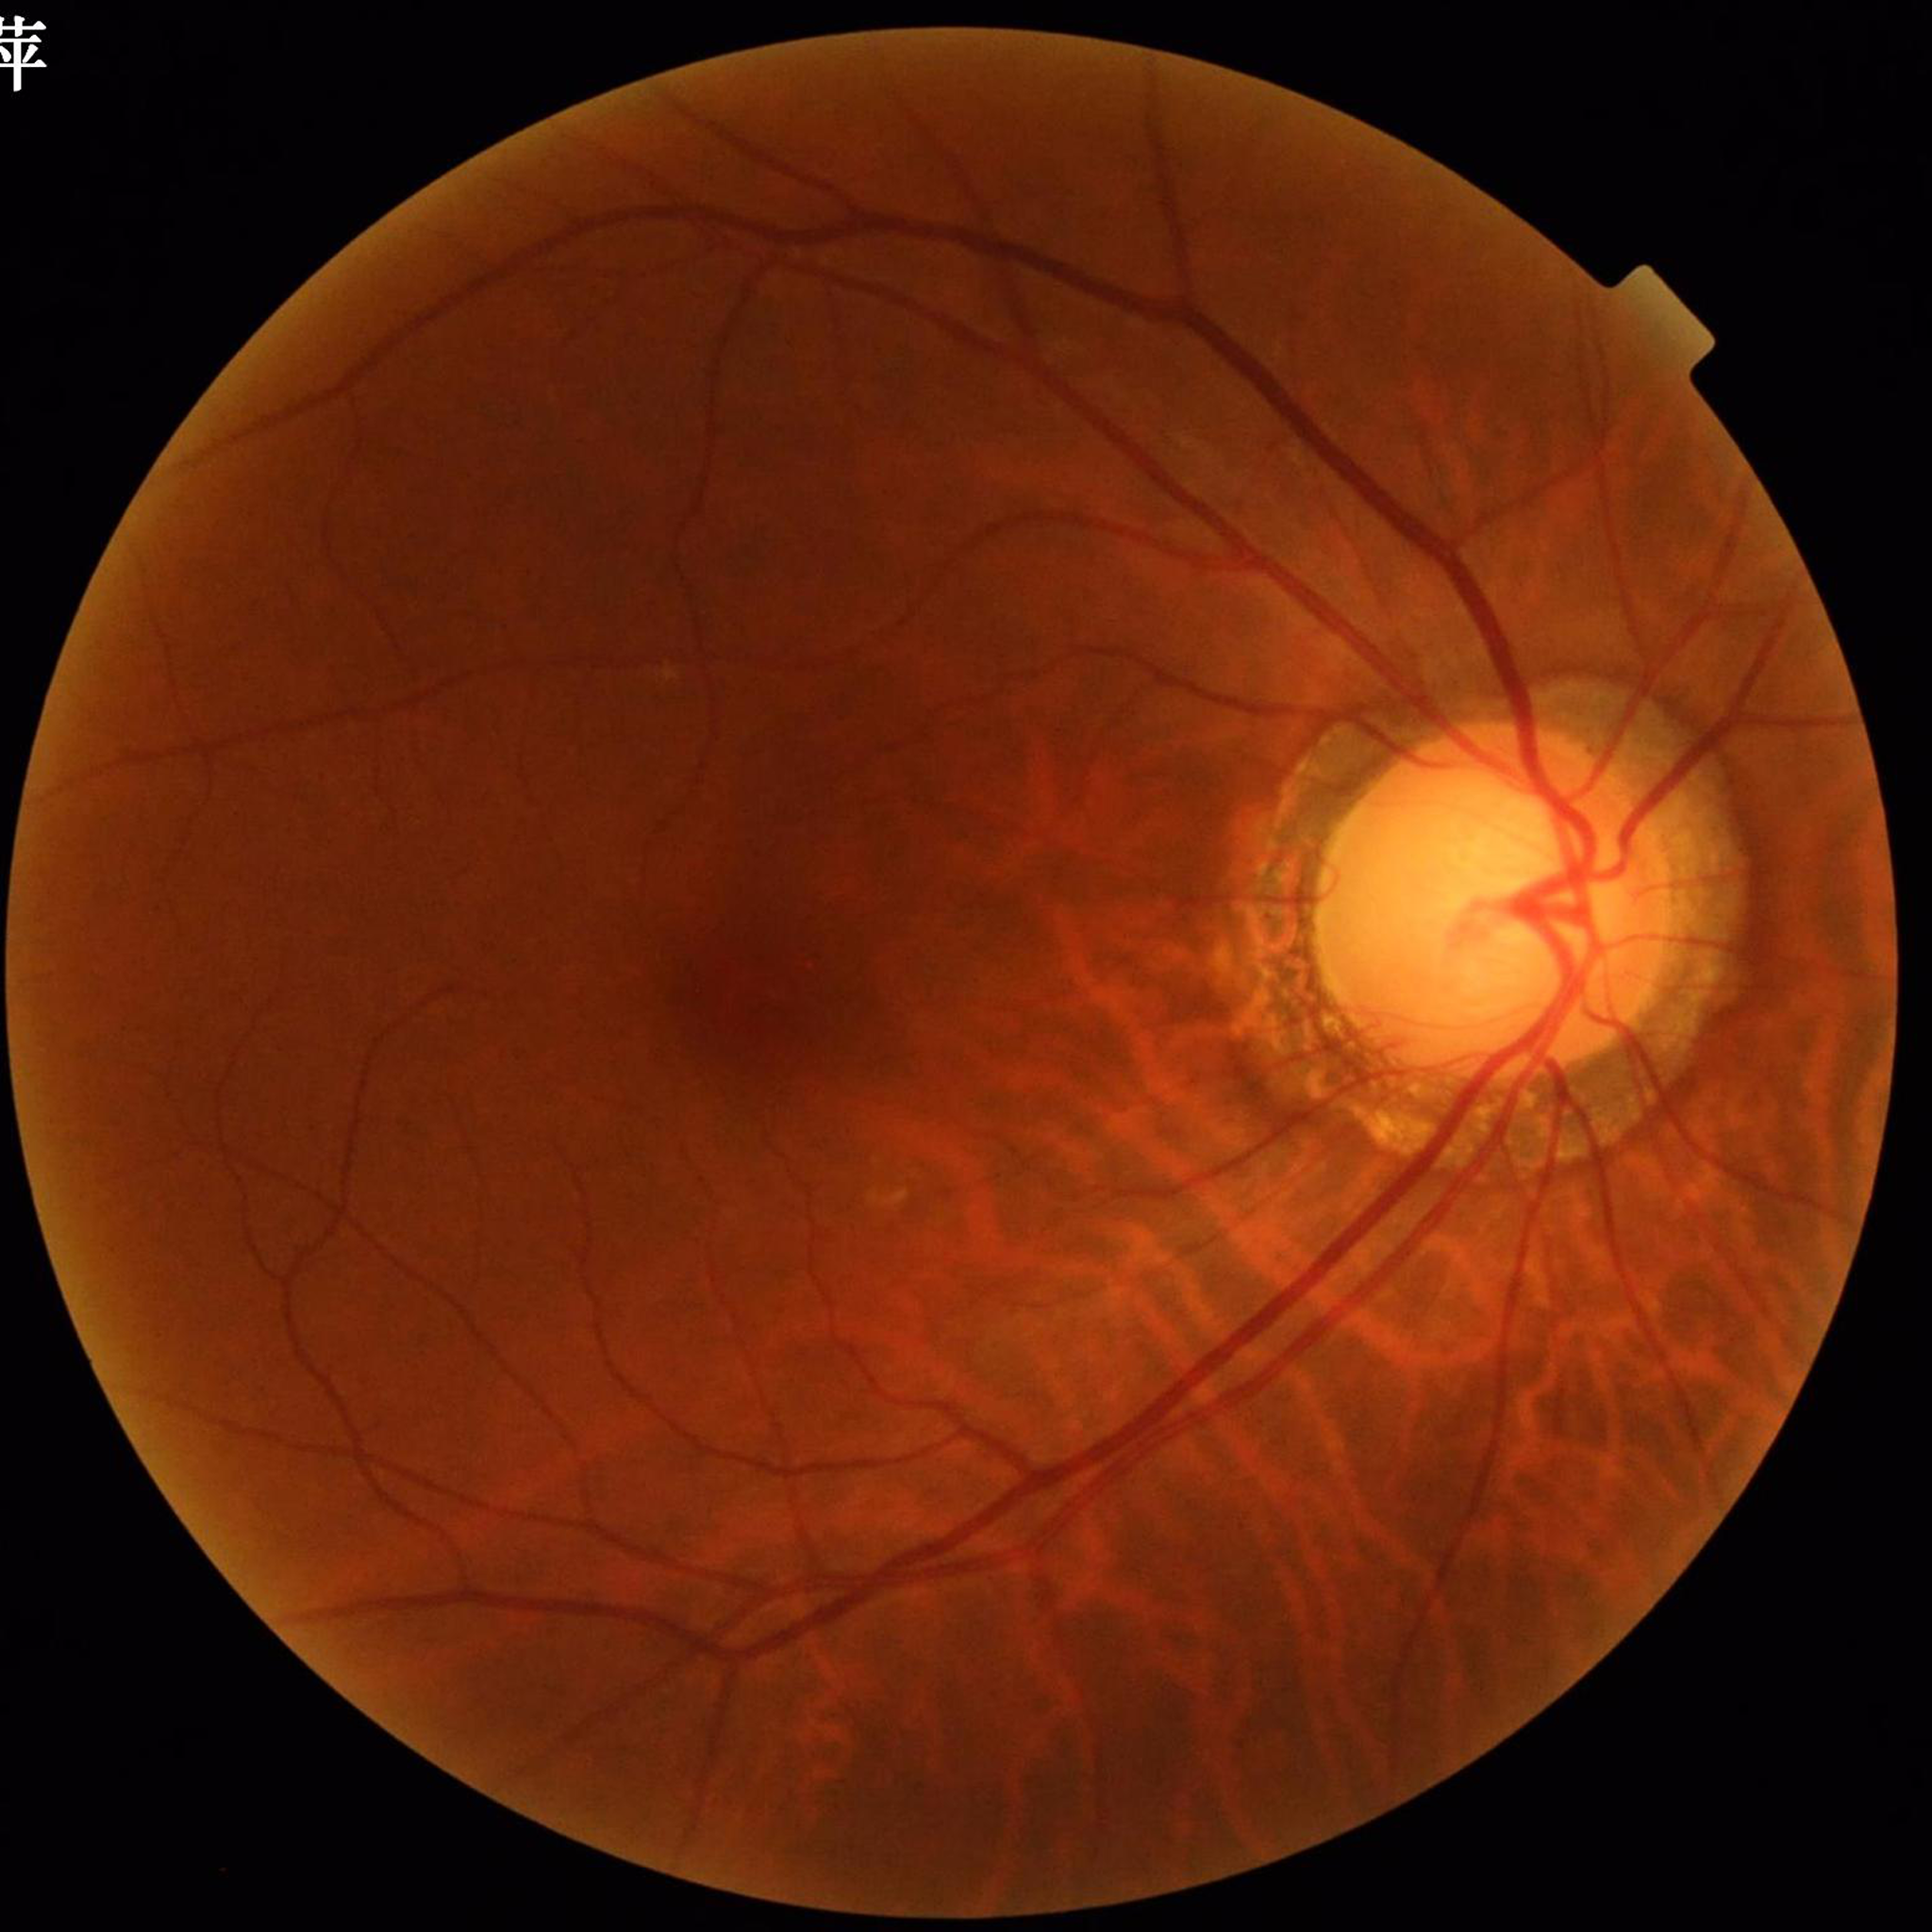
Patient diagnosed with glaucoma.
Image quality: good.